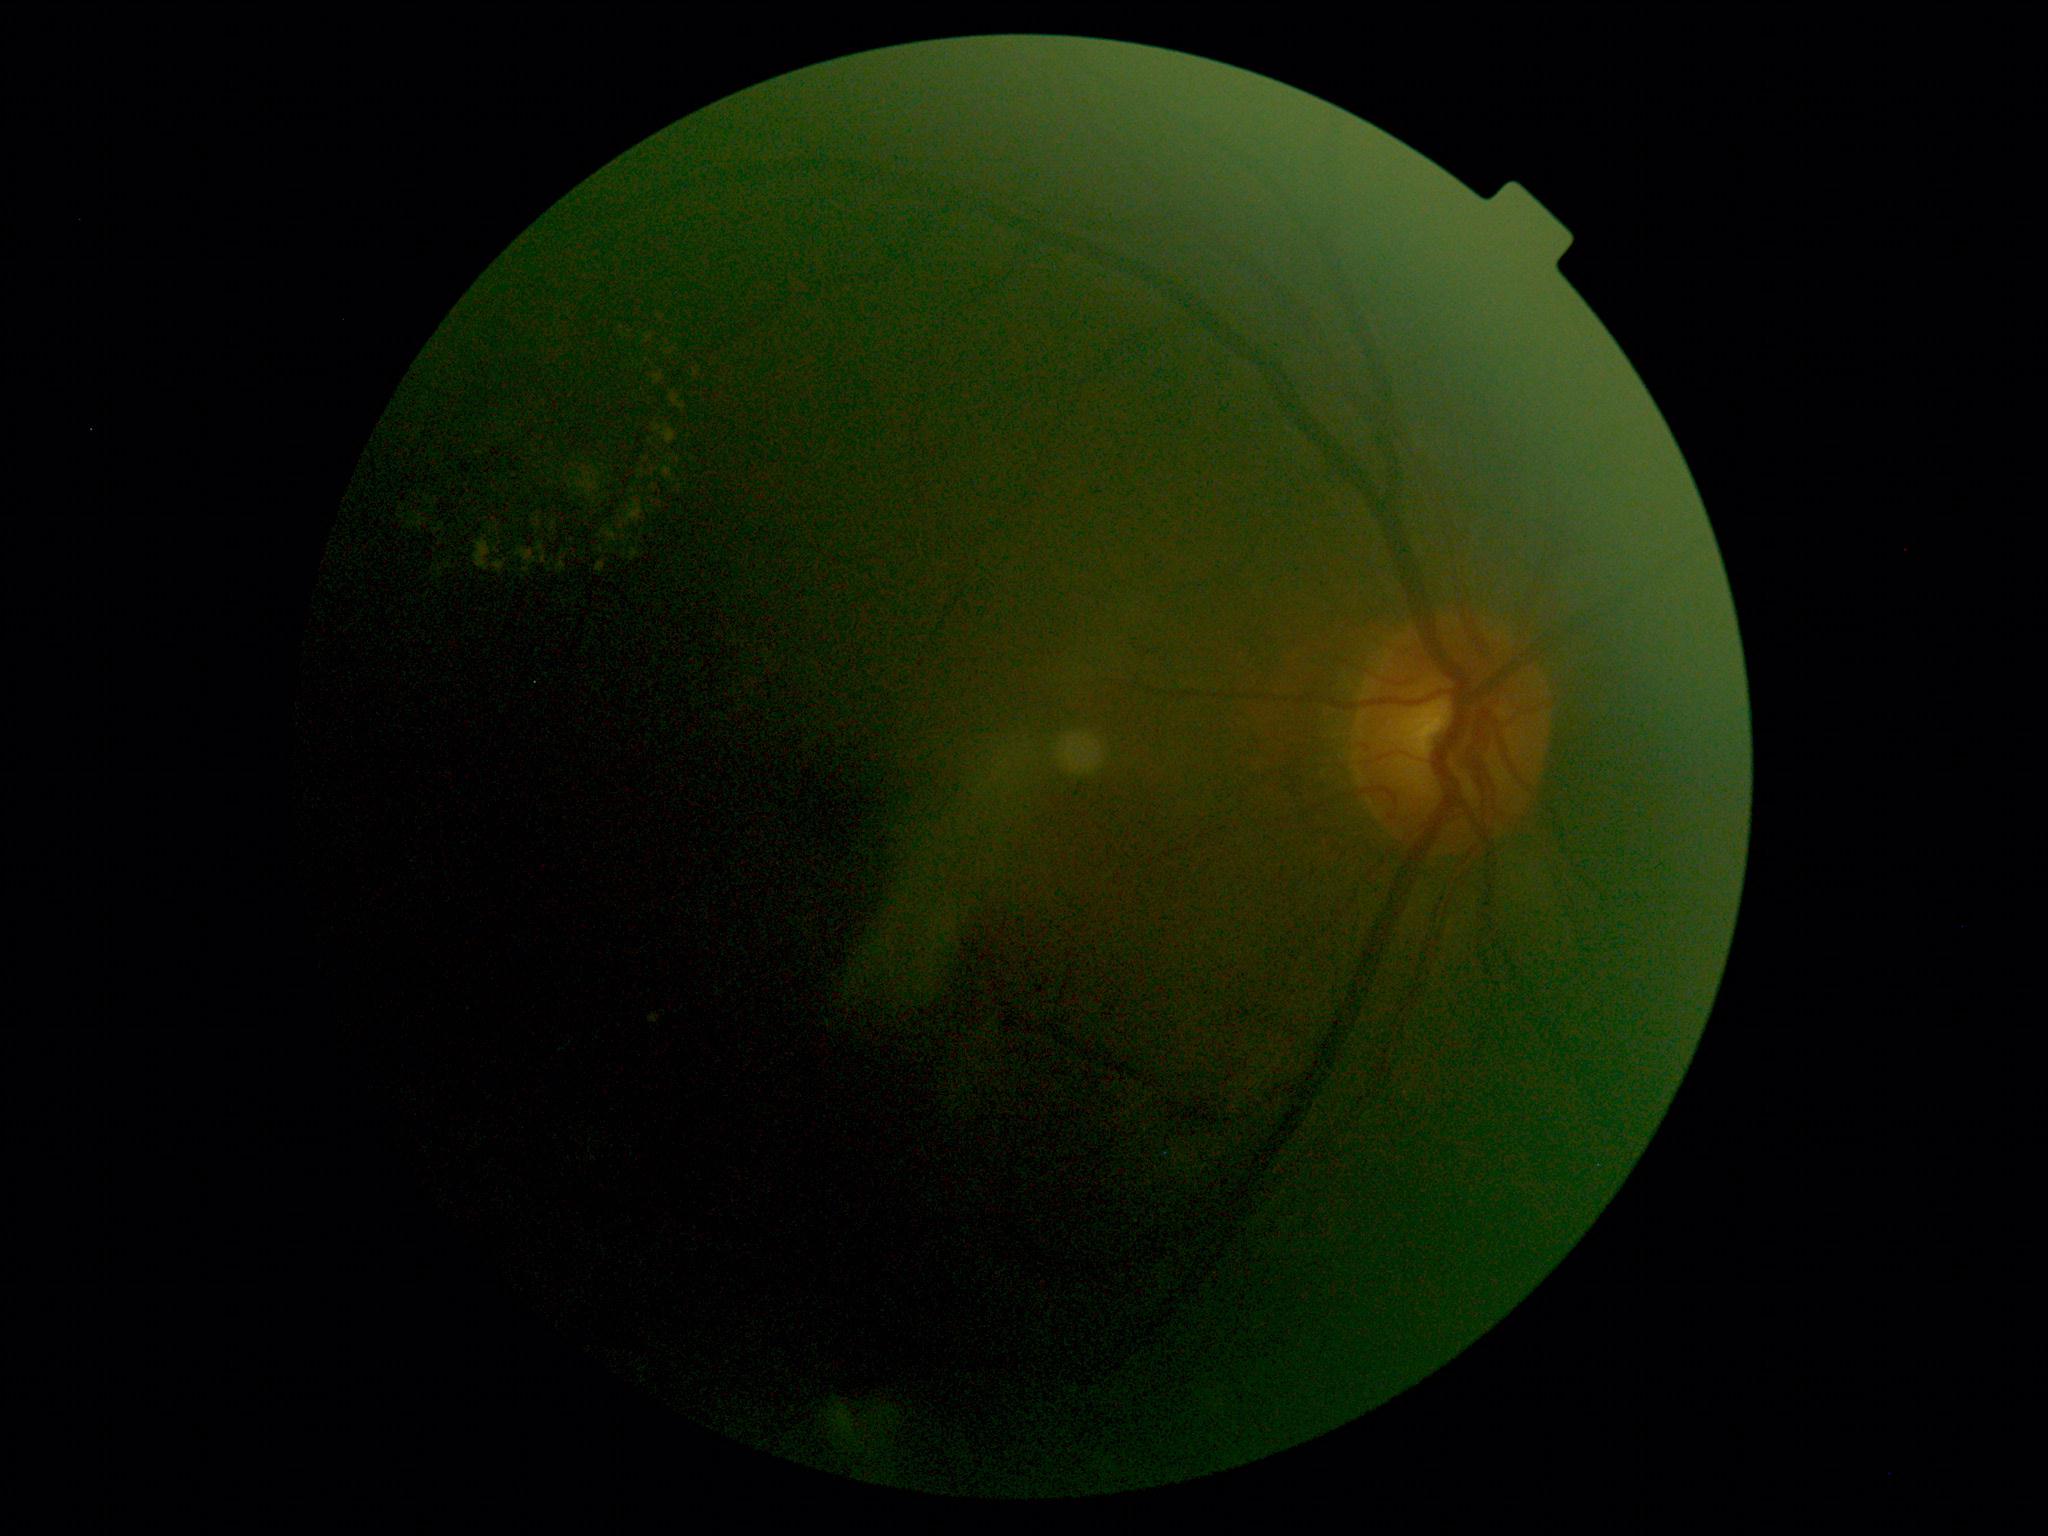
diabetic retinopathy grade: 2/4